Posterior pole color fundus photograph, no pharmacologic dilation, graded on the modified Davis scale, camera: NIDEK AFC-230: 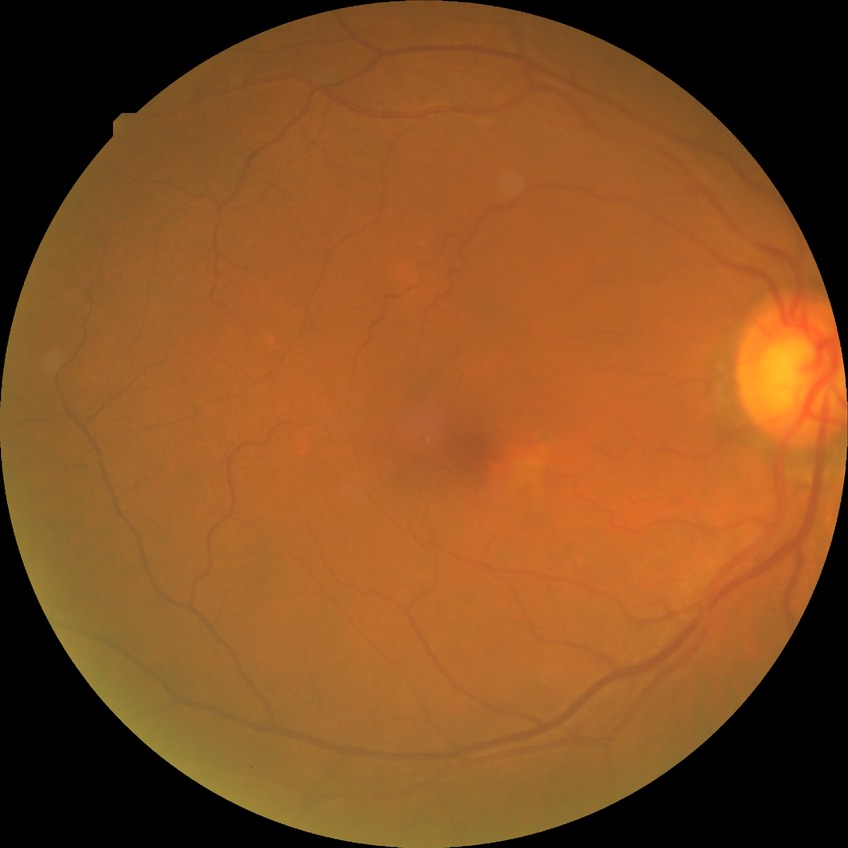

DR class: non-proliferative diabetic retinopathy. Davis DR grade: SDR.